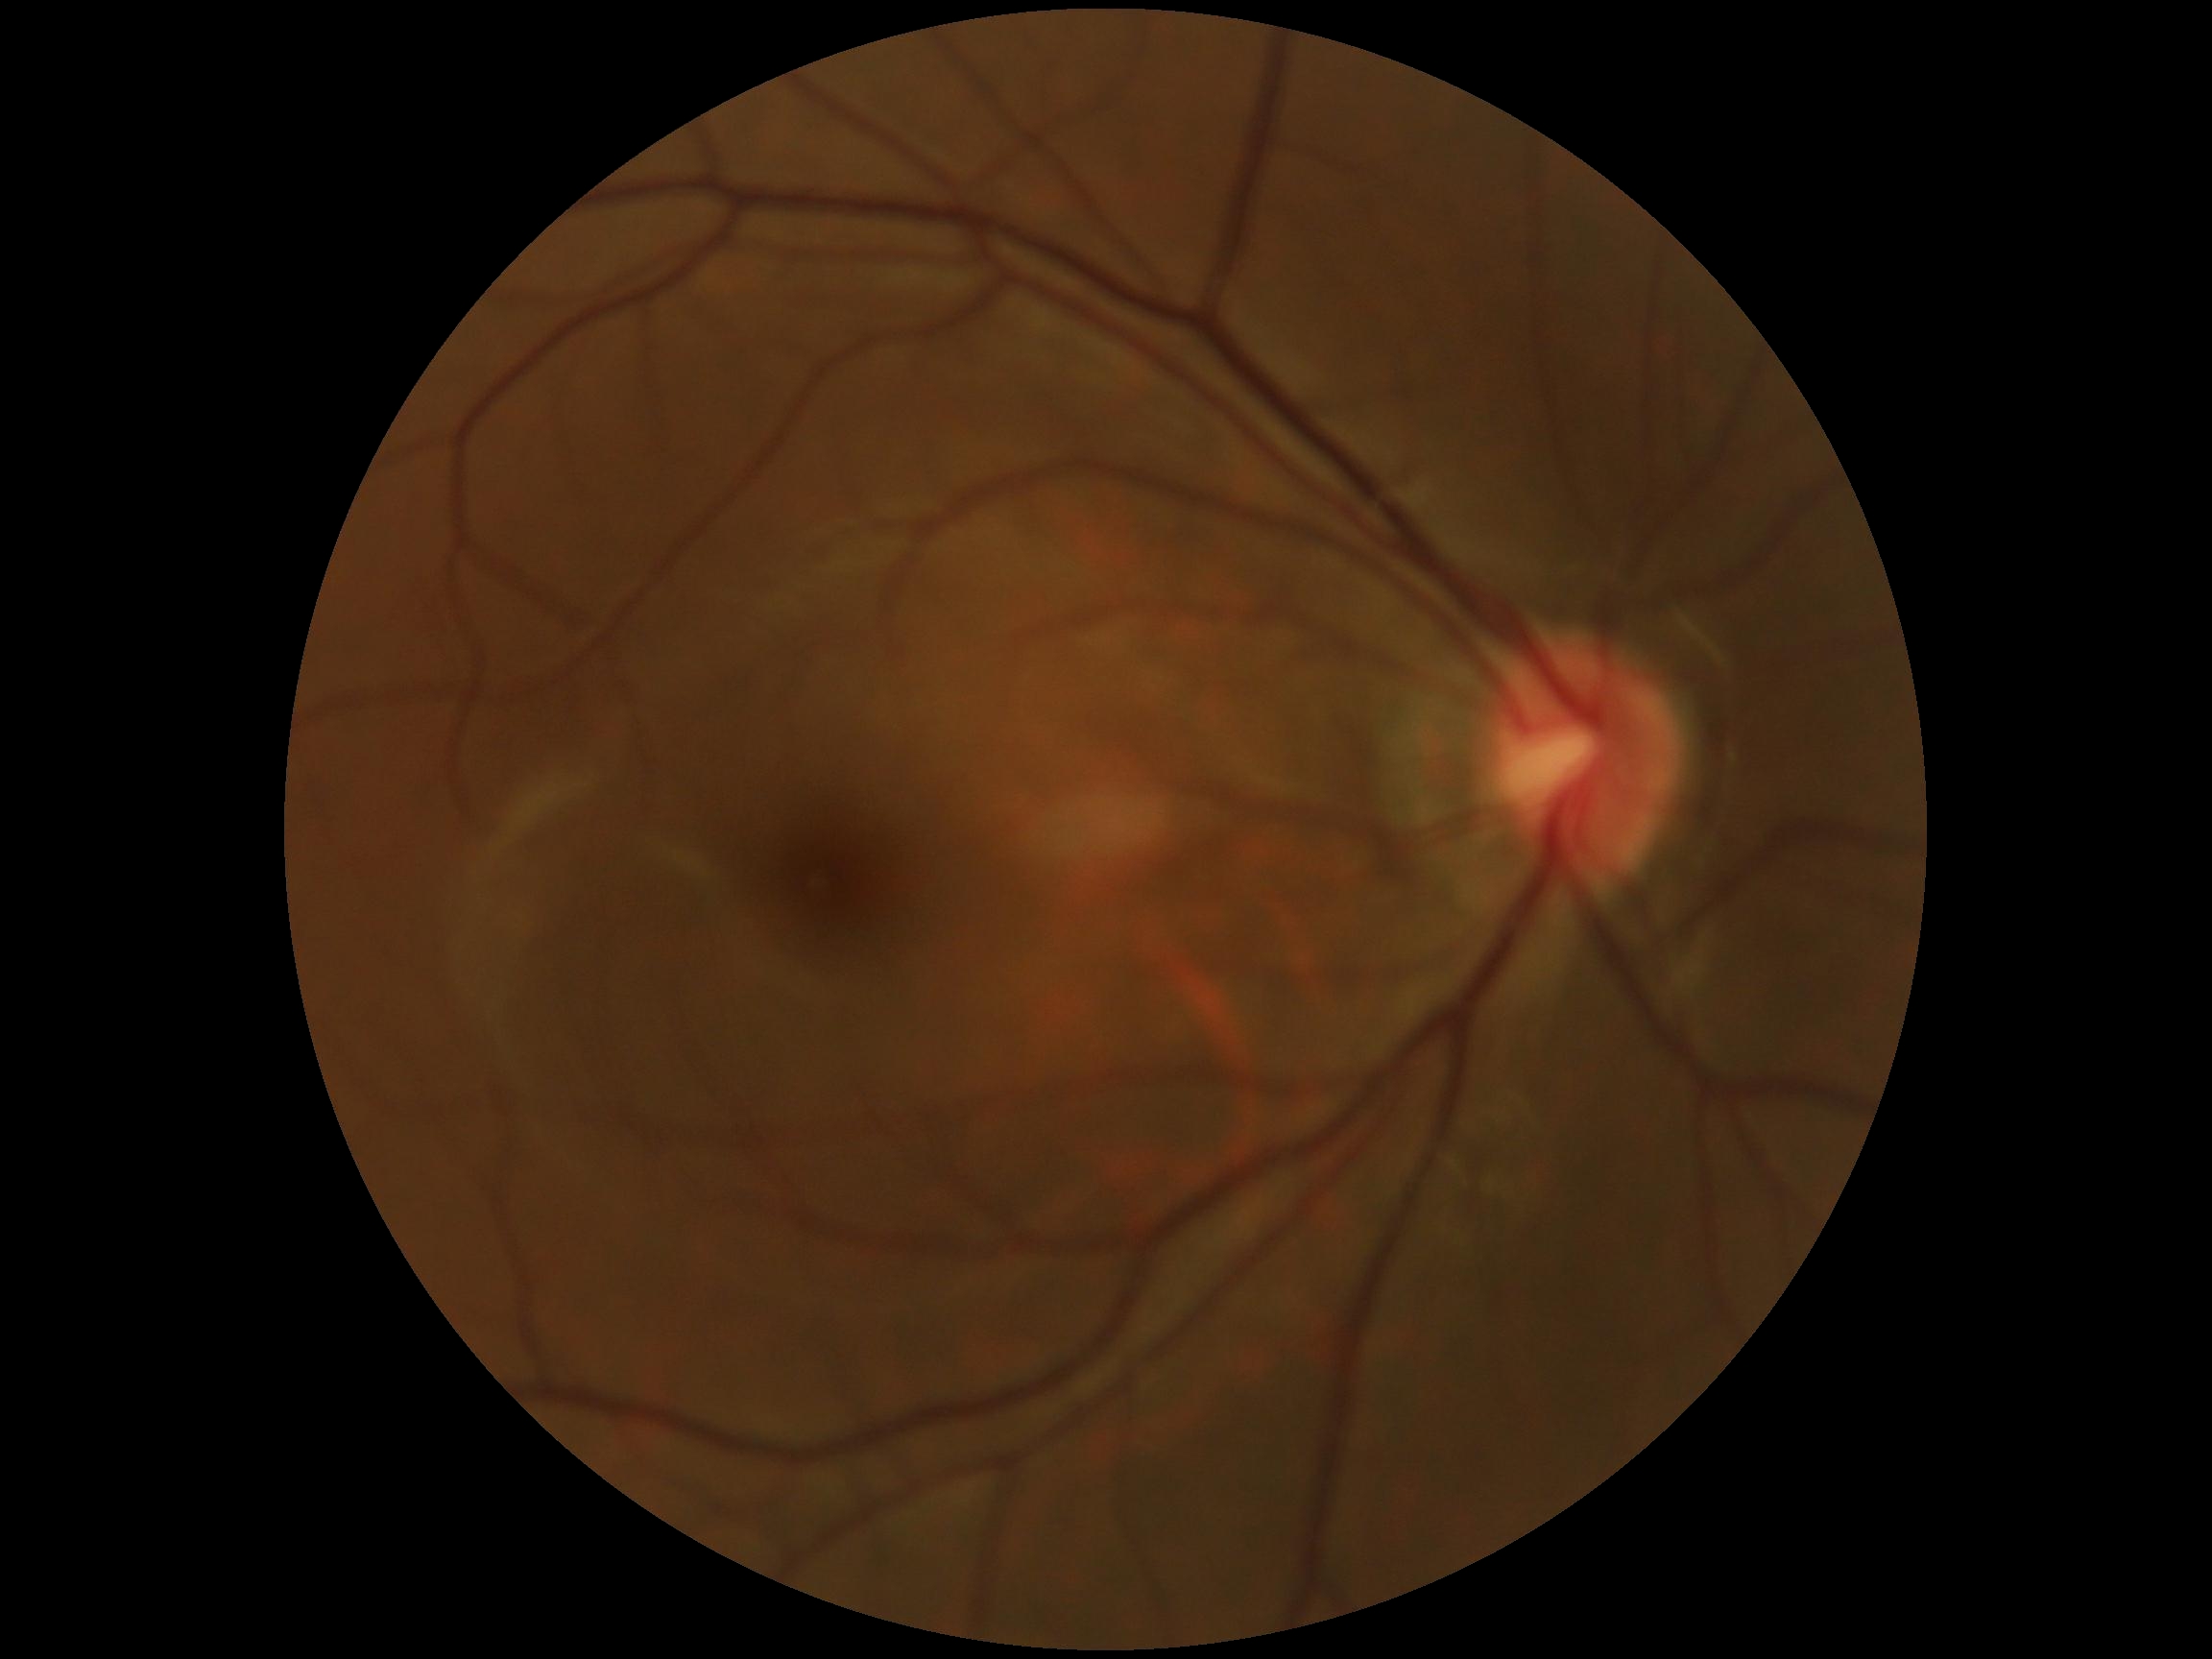 DR: no apparent retinopathy (grade 0).